Posterior pole color fundus photograph; camera: NIDEK AFC-230; 848 x 848 pixels; graded on the modified Davis scale — 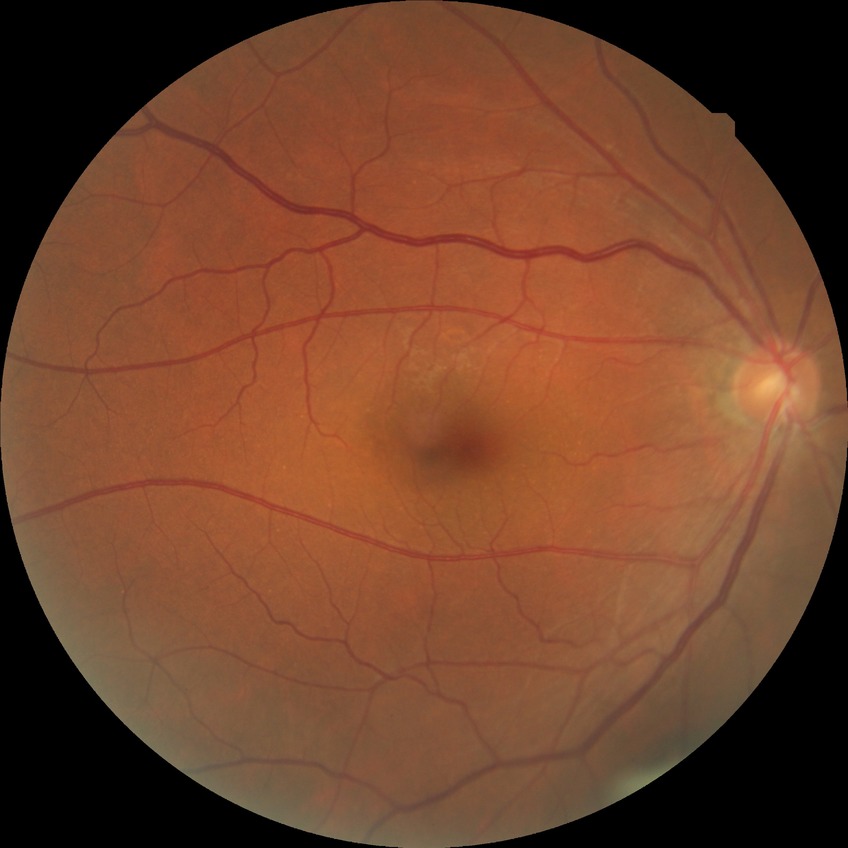

Diabetic retinopathy (DR) is no diabetic retinopathy (NDR).